240x240, color fundus photograph.
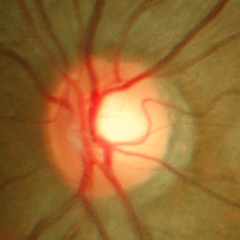
The image shows no glaucomatous changes.